130° field of view (Clarity RetCam 3); wide-field fundus image from infant ROP screening:
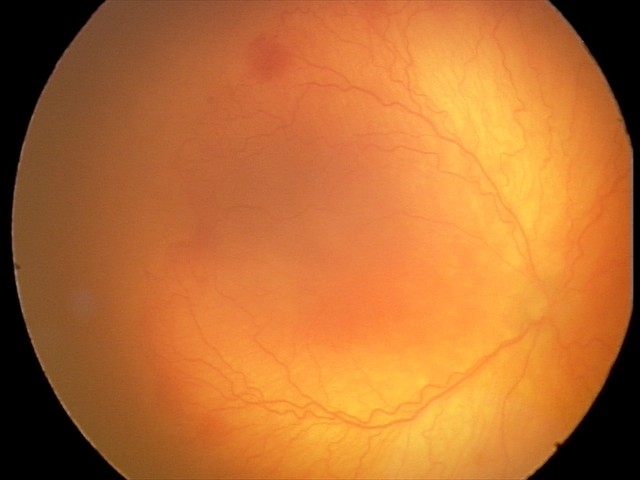 Series diagnosed as aggressive retinopathy of prematurity — rapidly progressive severe ROP with prominent plus disease, often without classic stage progression. Plus disease present.